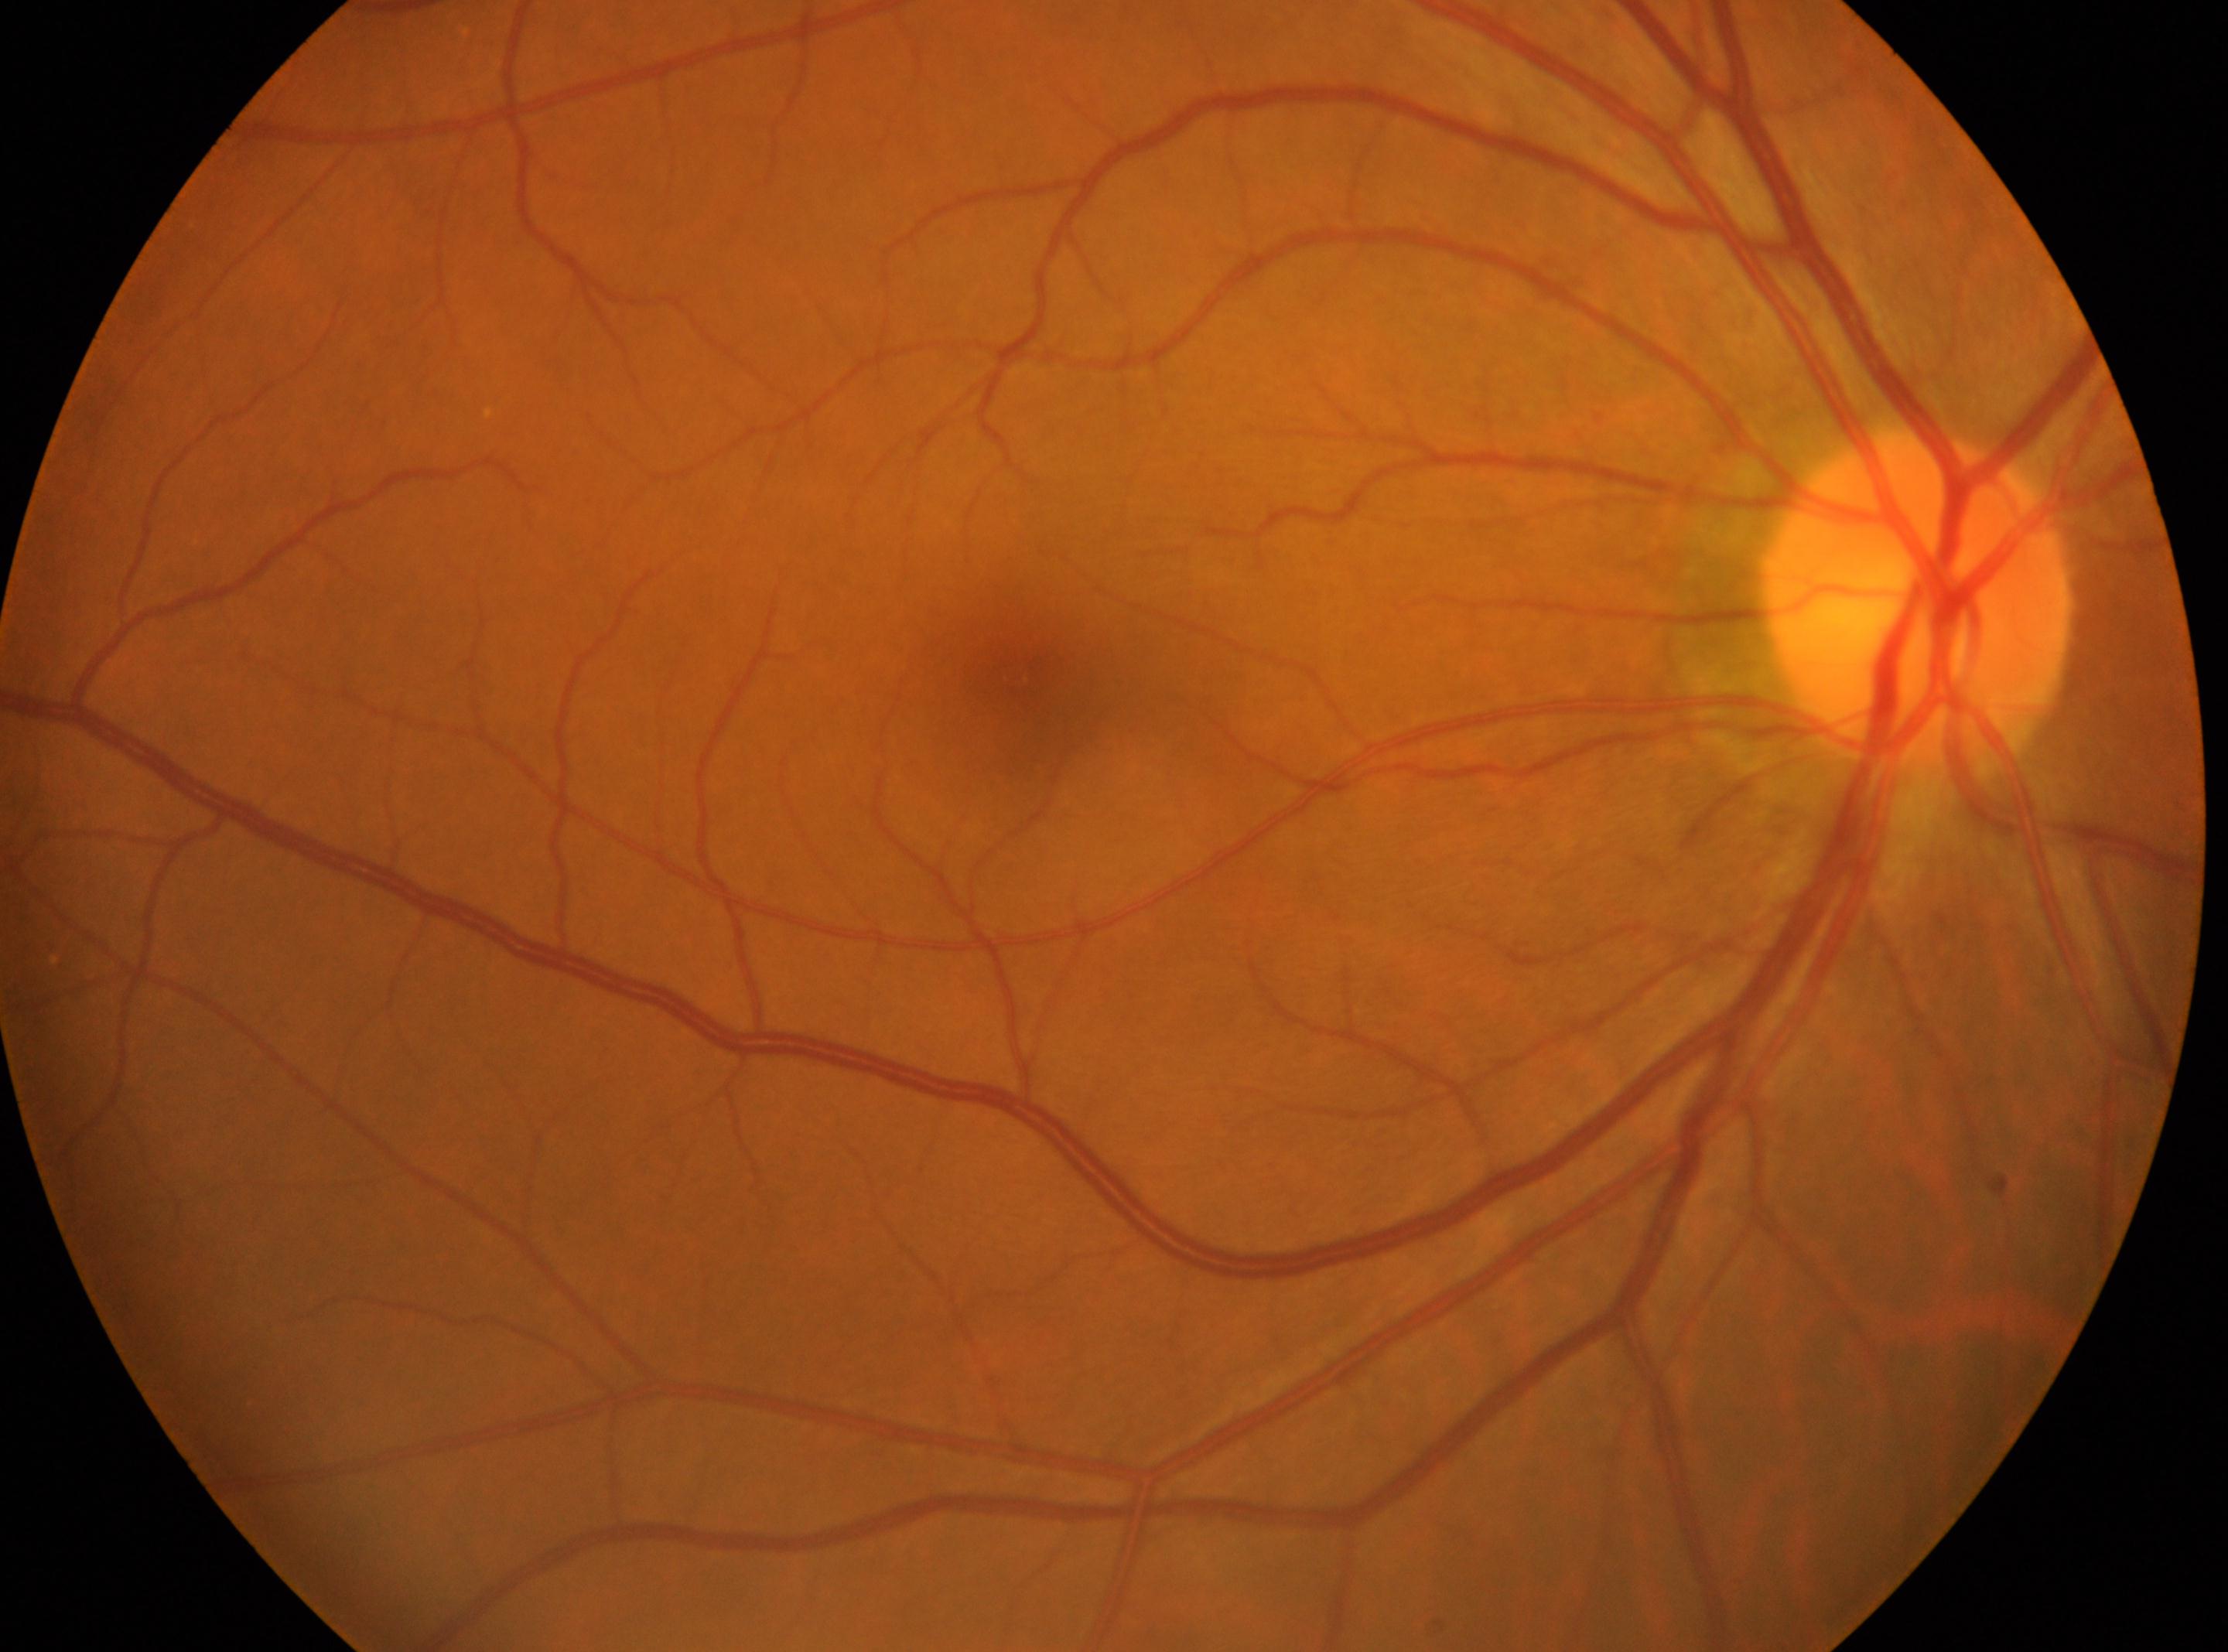

laterality = the right eye, diabetic retinopathy grade = no apparent diabetic retinopathy (0), fovea = (x: 1017, y: 676), optic disc = (x: 1915, y: 596).